Captured with the Clarity RetCam 3 (130° field of view) · wide-field contact fundus photograph of an infant · image size 640x480.
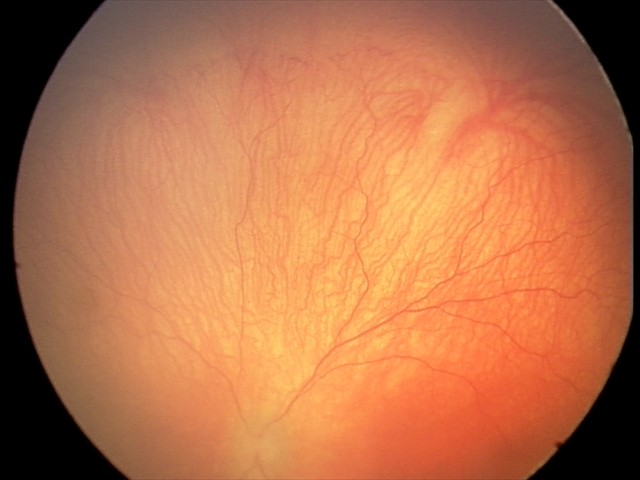
From an examination with diagnosis of aggressive retinopathy of prematurity.
Plus disease present.